FOV: 45 degrees: 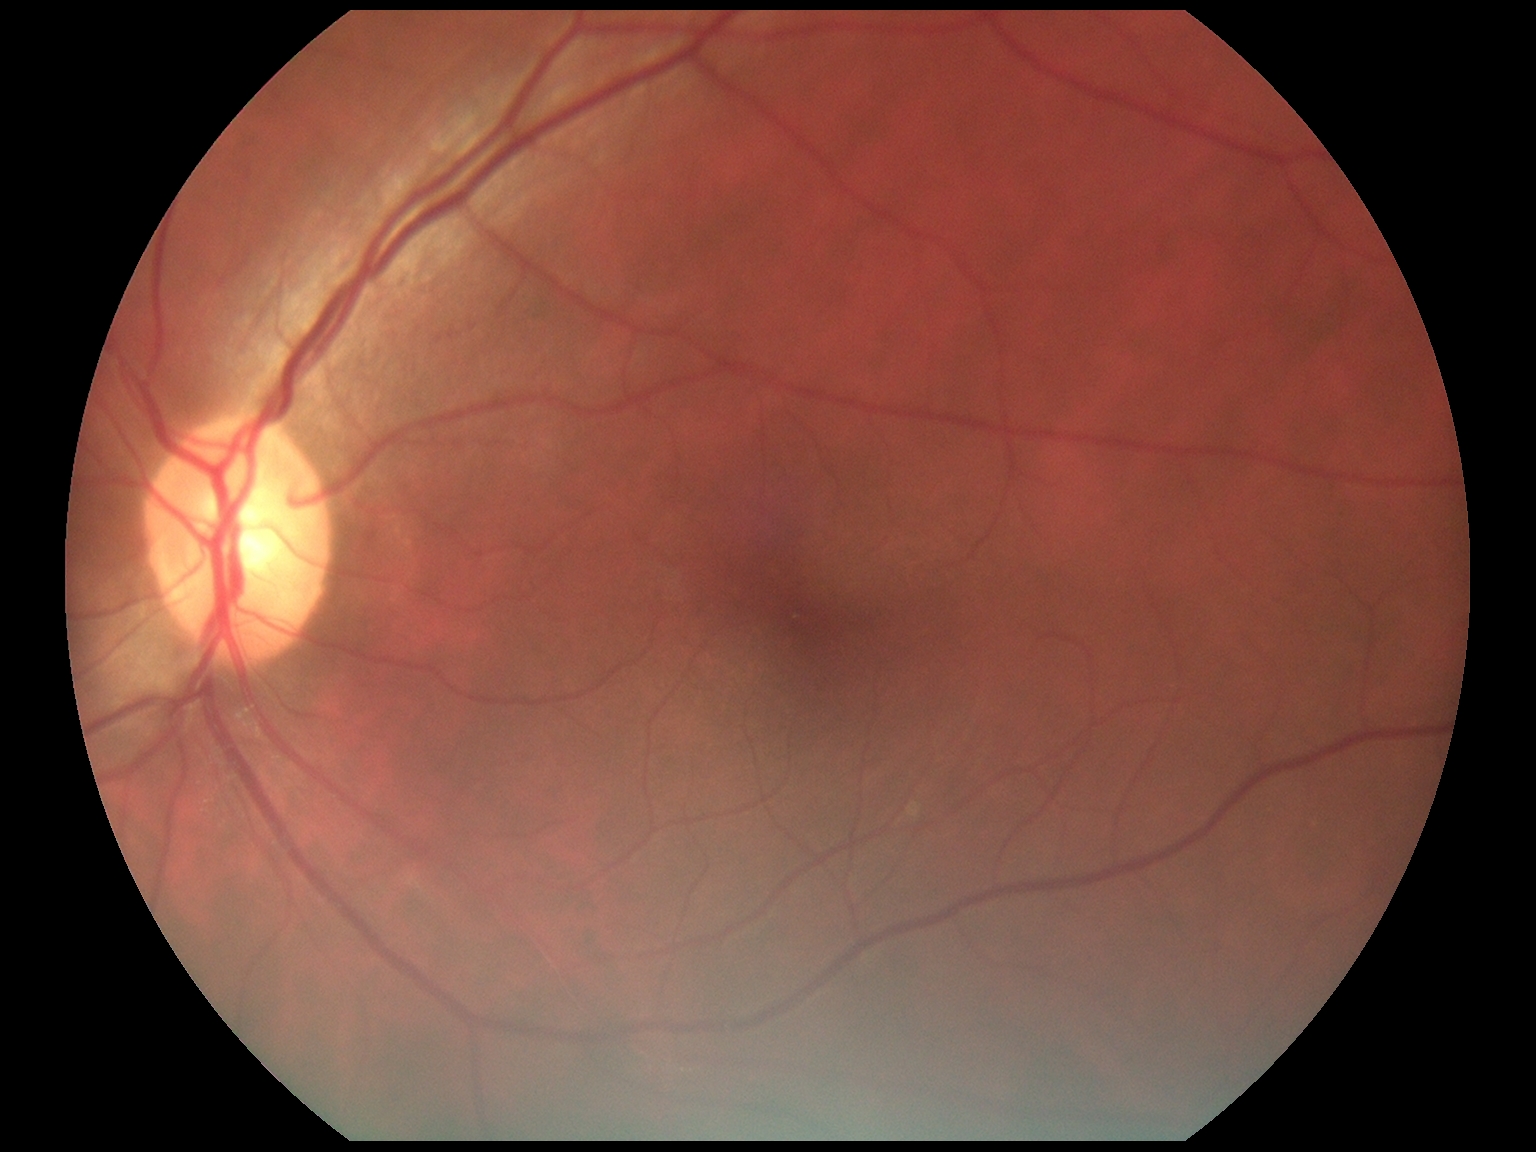

DR severity: 0/4. No diabetic retinal disease findings.